45° field of view — 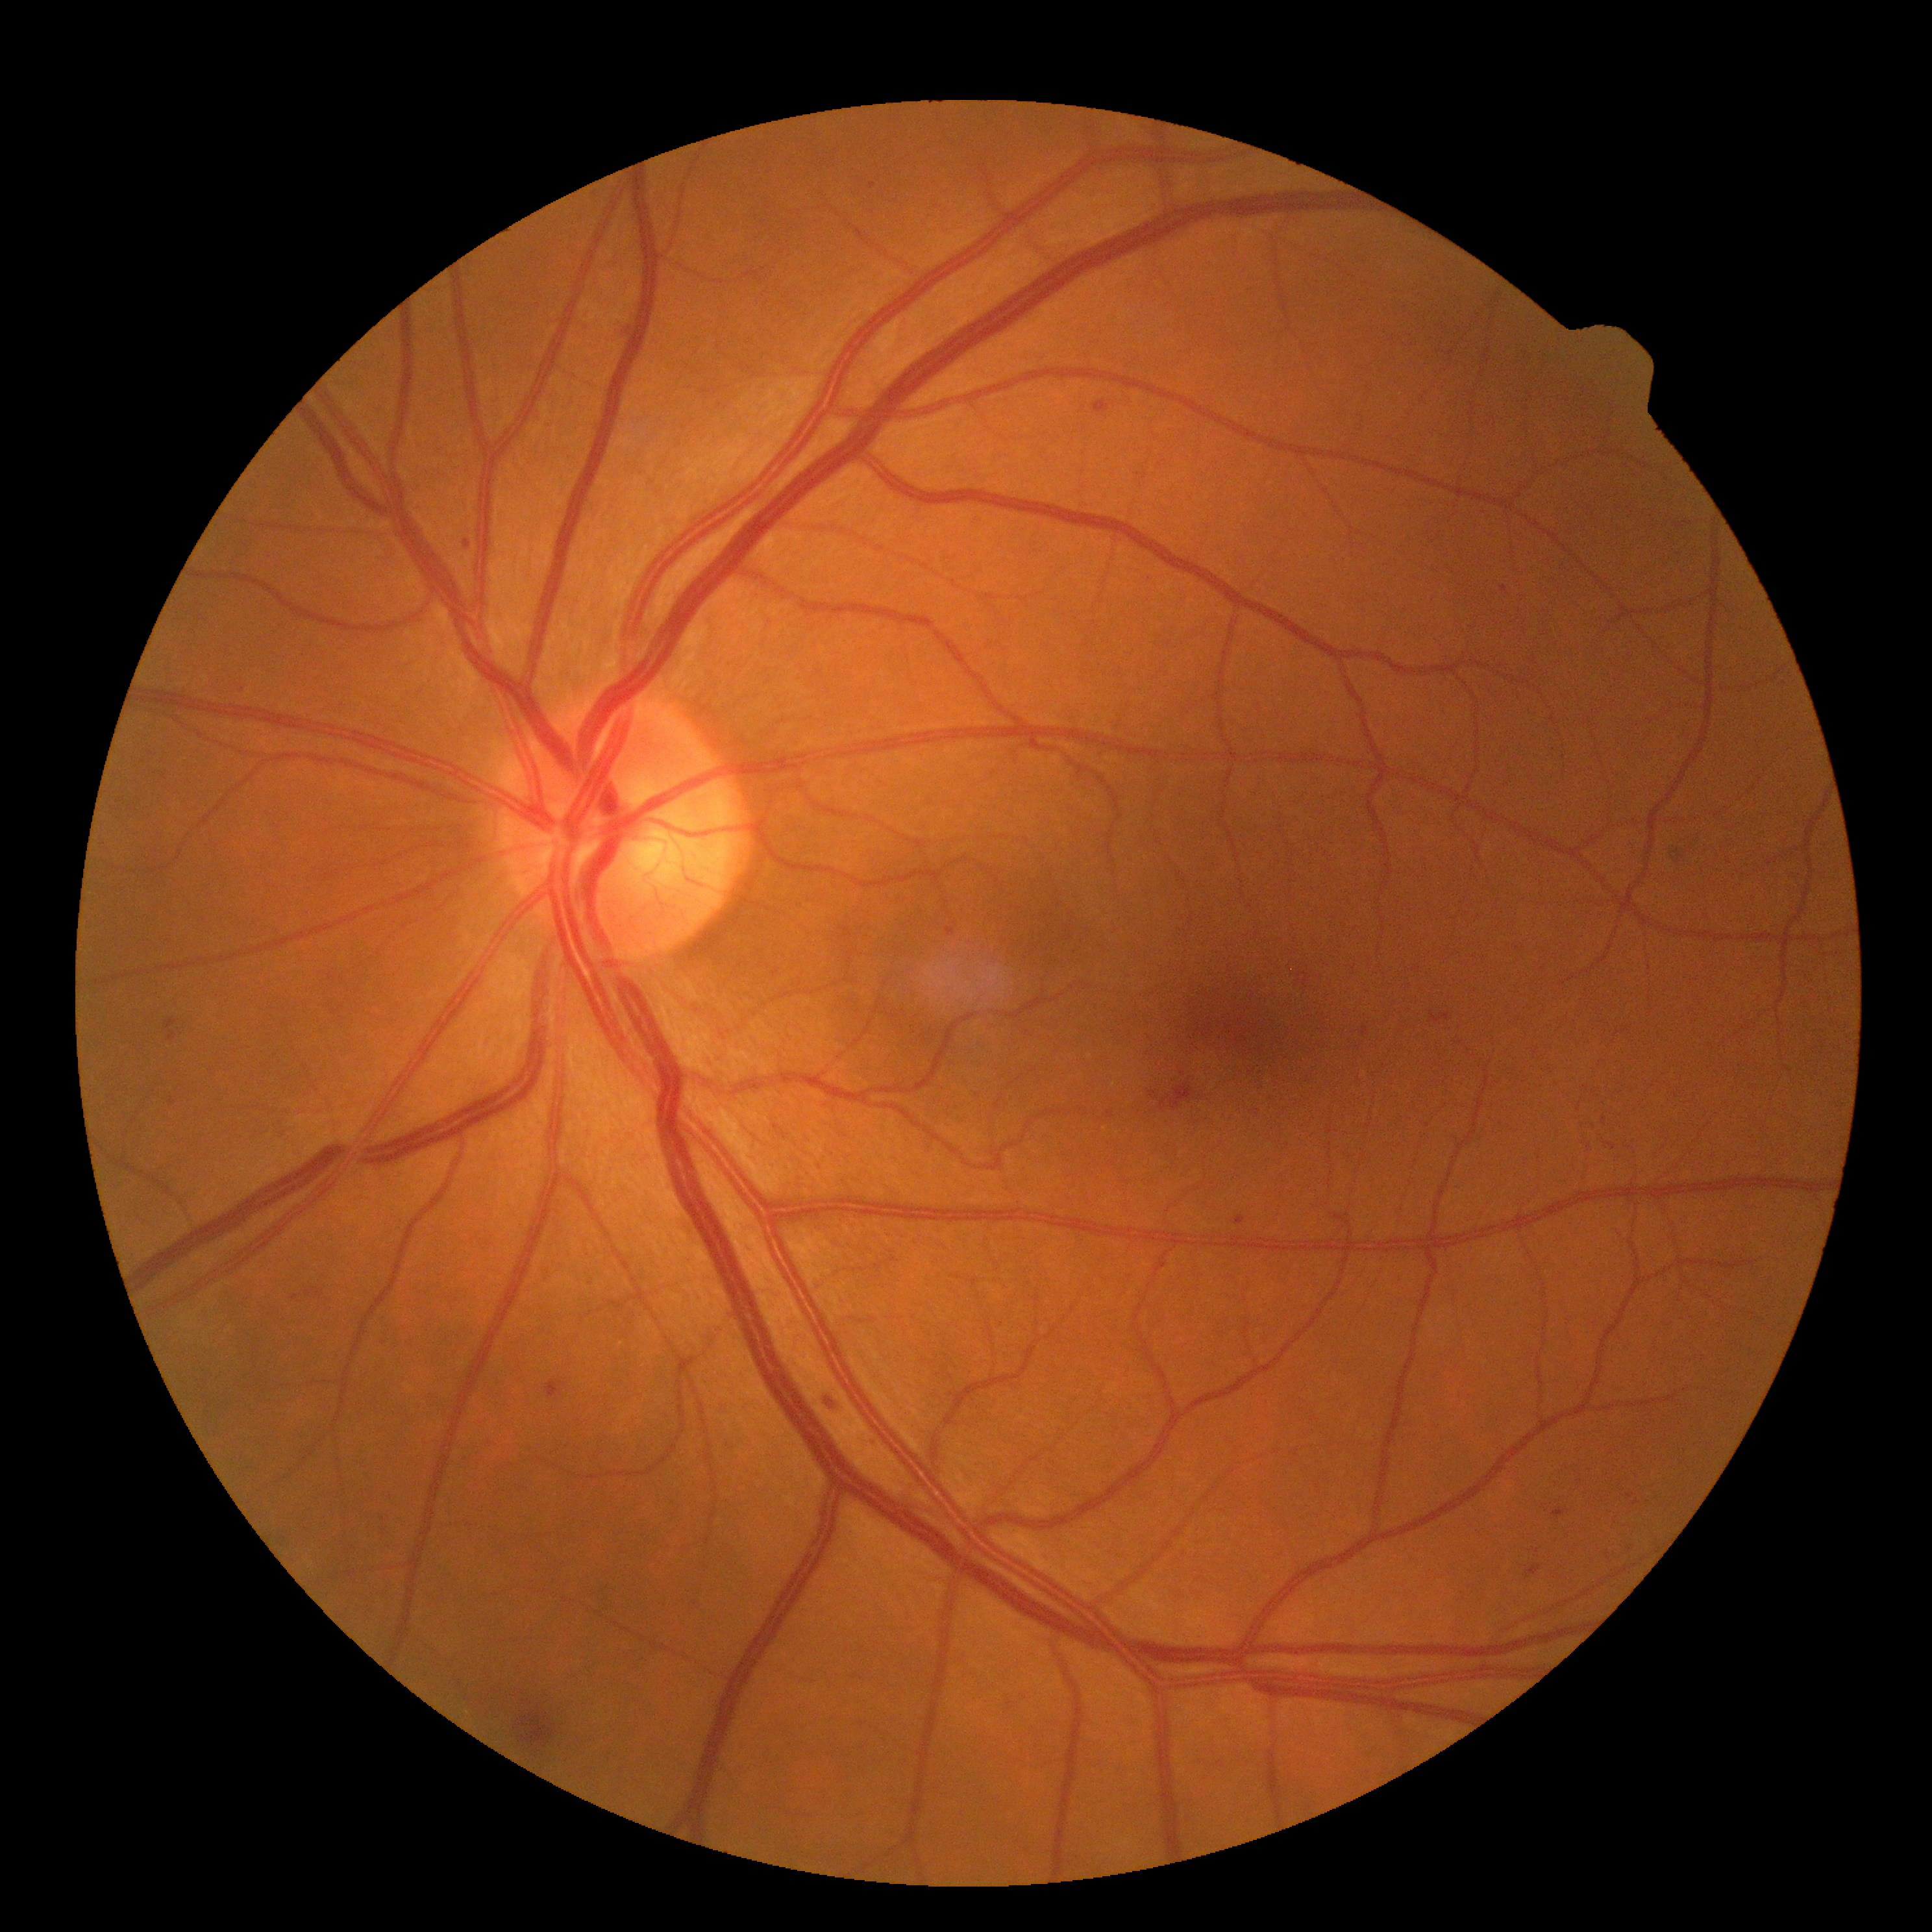
dr_grade: moderate non-proliferative diabetic retinopathy (2)